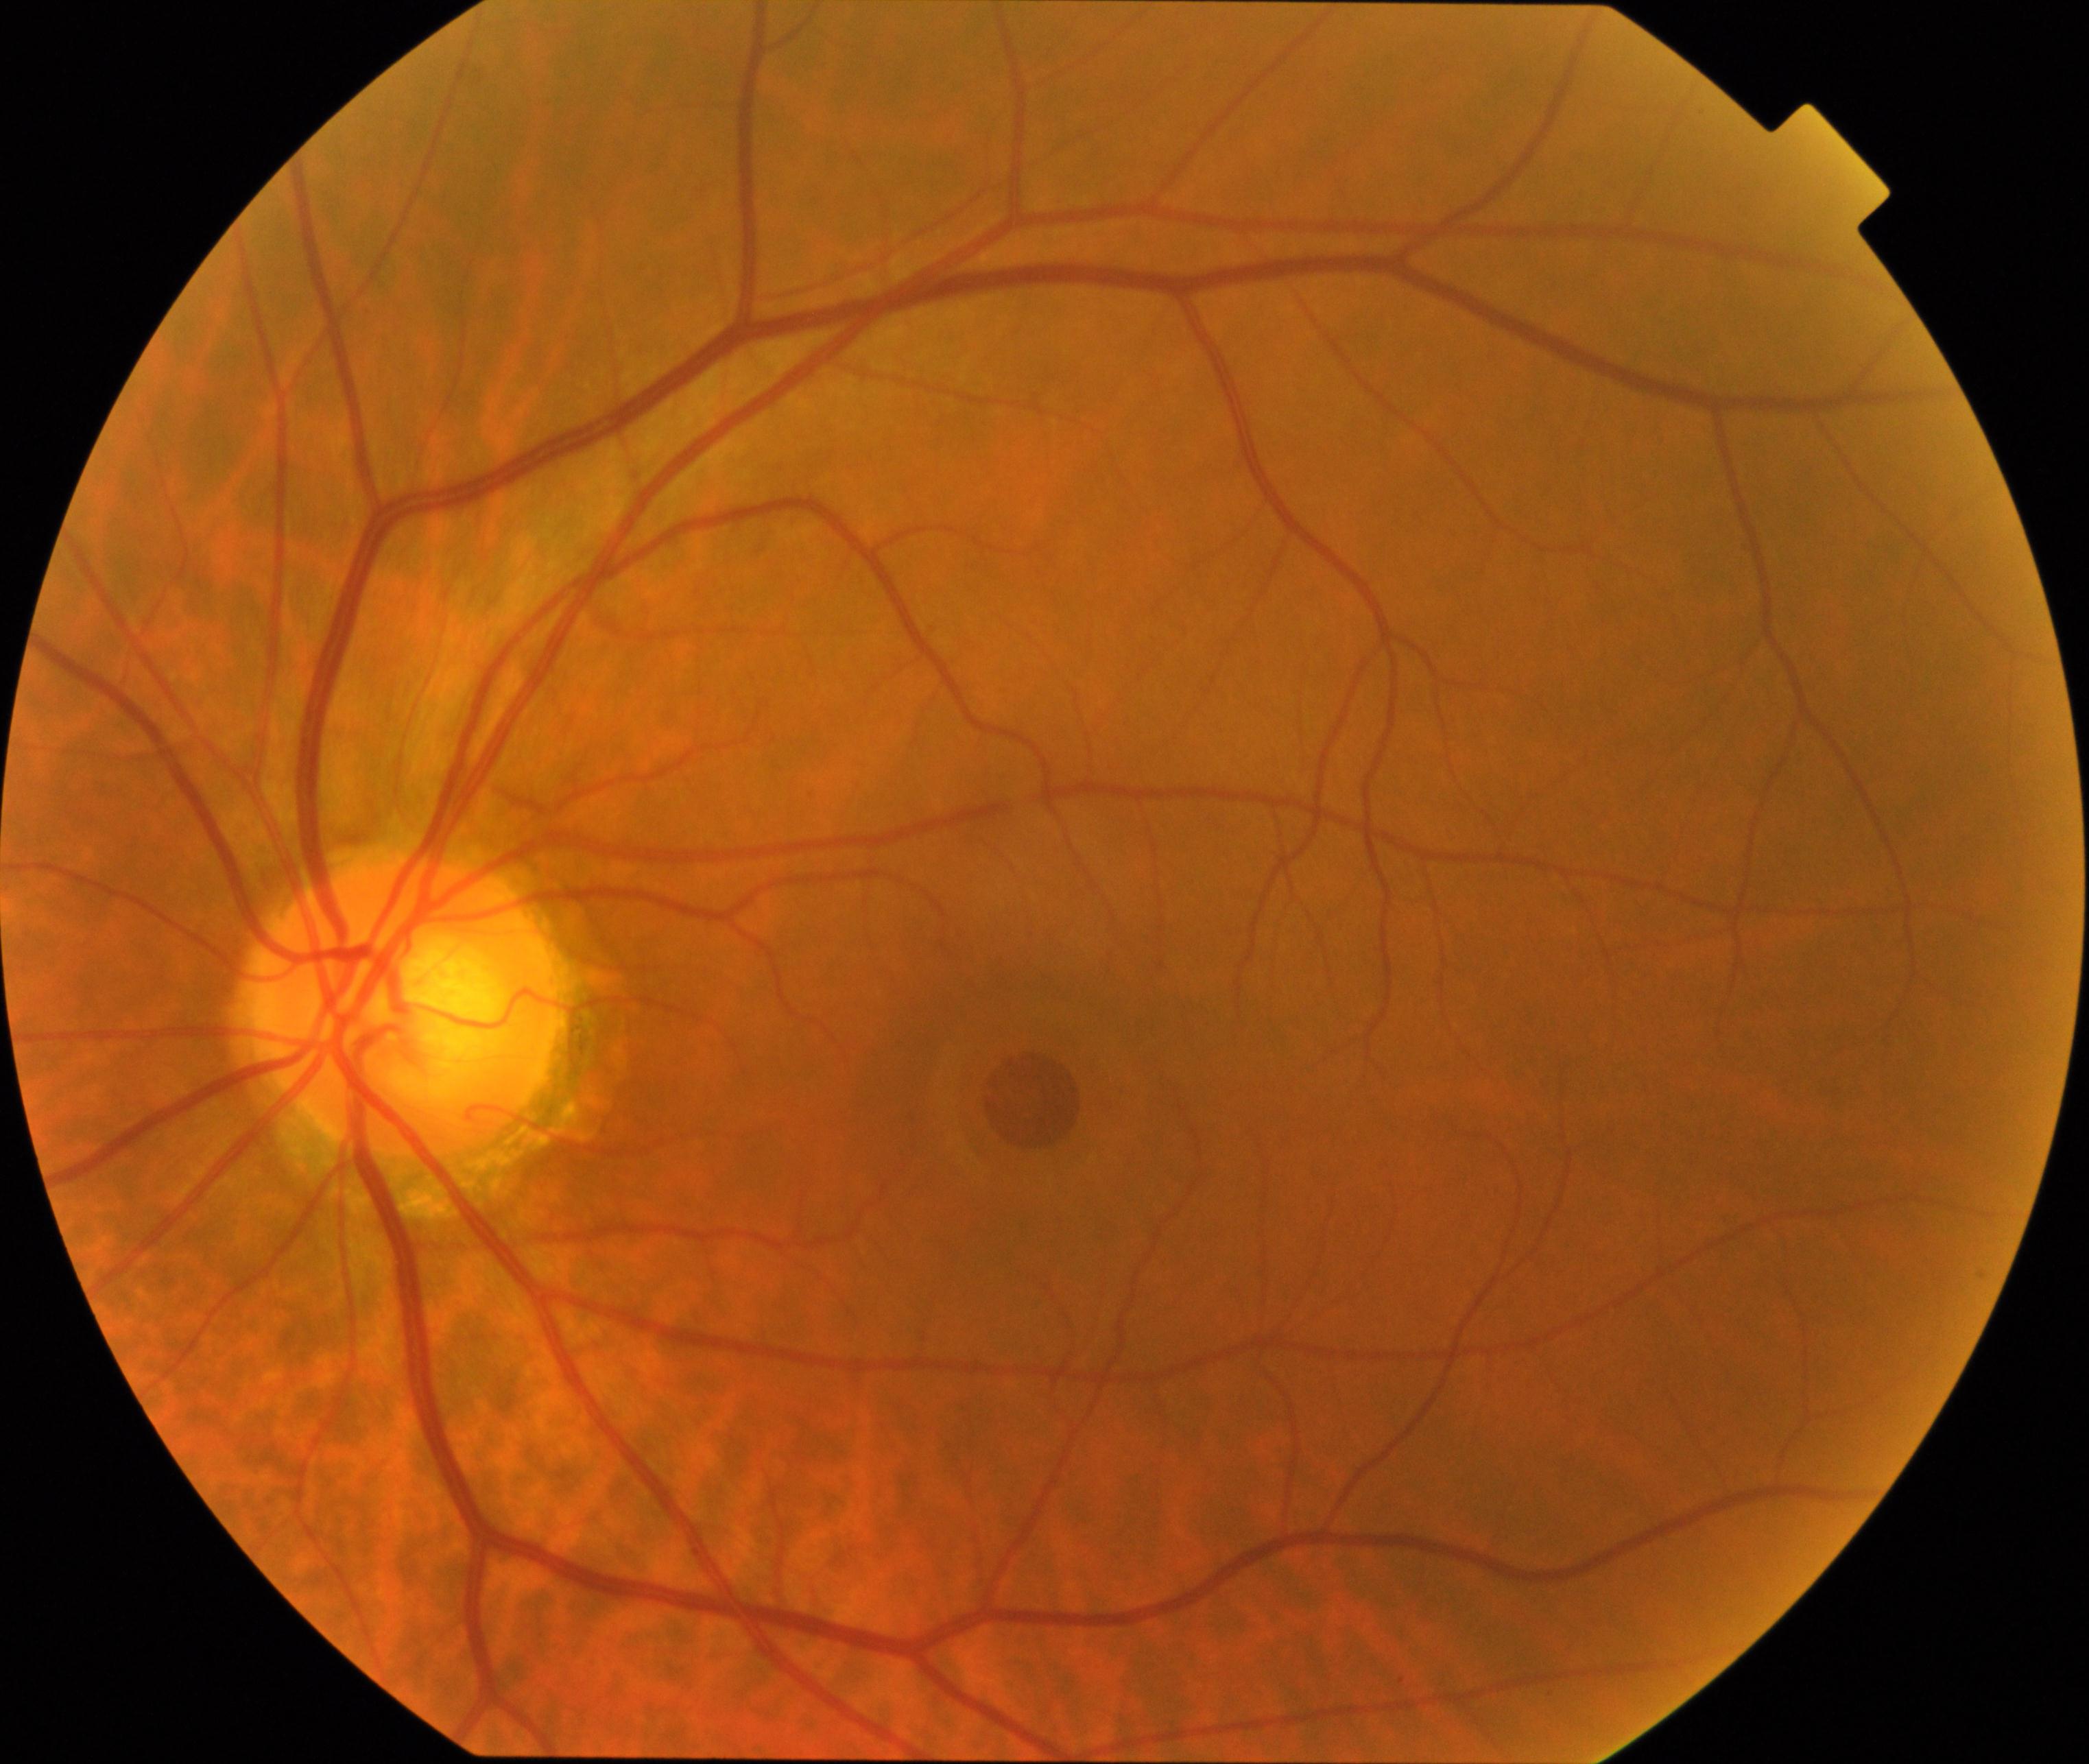
Findings consistent with macular hole. Defined by central foveal defect, round or oval, sometimes with multiple yellow deposits within the crater or a surrounding cuff of subretinal fluid.